640 by 480 pixels. Infant wide-field fundus photograph
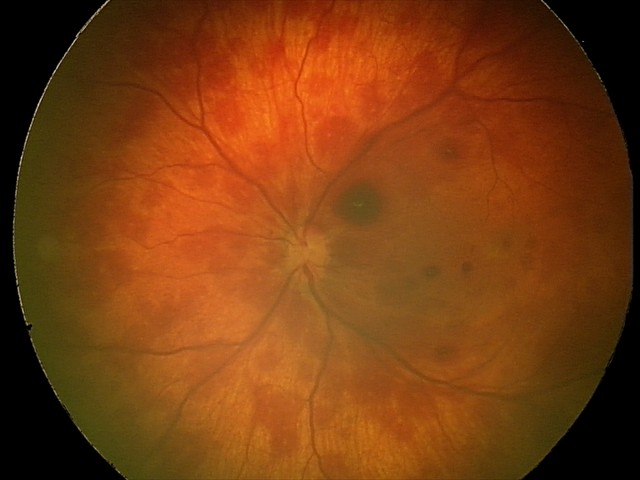

Diagnosis from this screening exam: retinal hemorrhages.